Acquired on the Natus RetCam Envision; wide-field fundus photograph from neonatal ROP screening
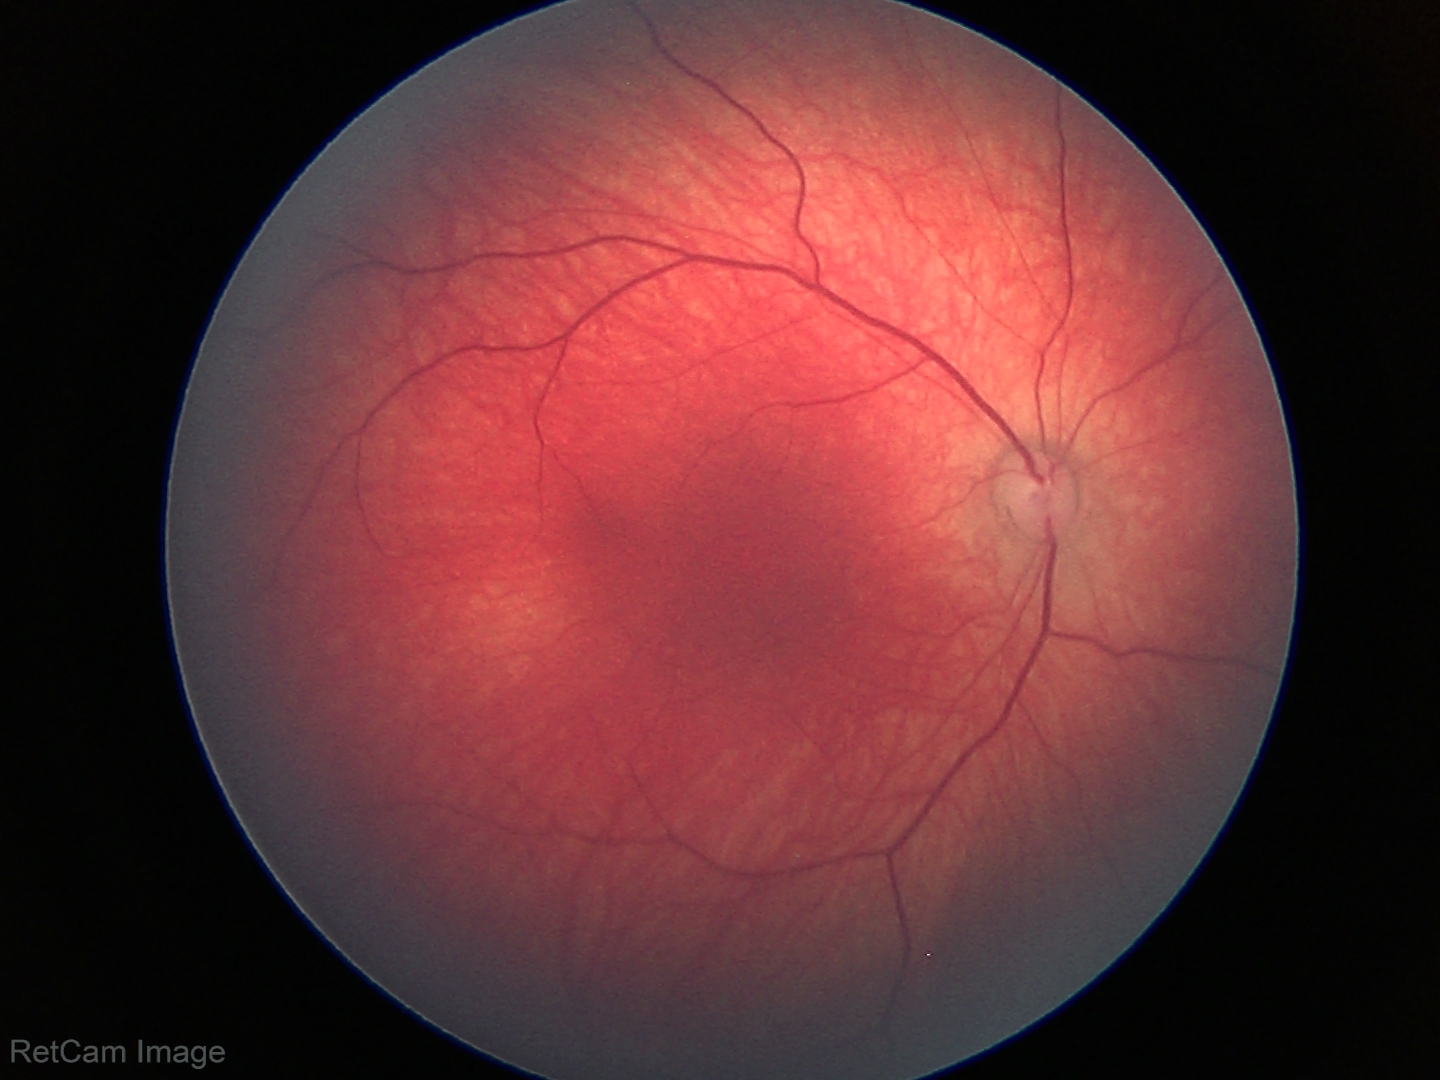

Q: What is the screening diagnosis?
A: normal retinal appearance